Without pupil dilation. 45-degree field of view. Fundus photo:
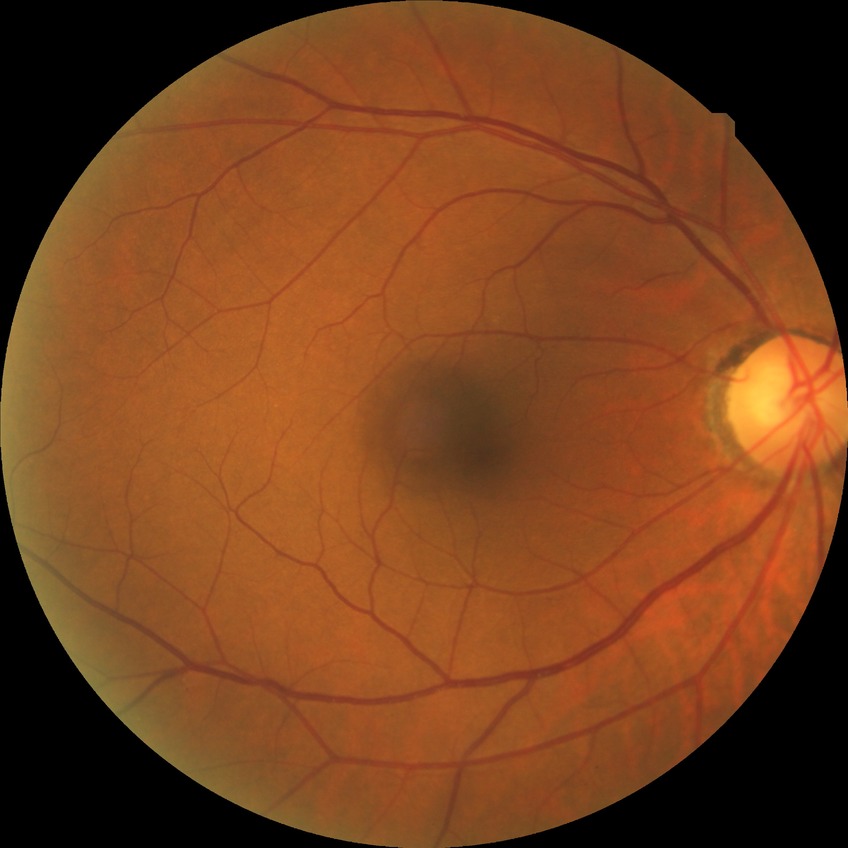 davis_grade: no diabetic retinopathy (NDR)